Image size 2212x1659 · retinal fundus photograph:
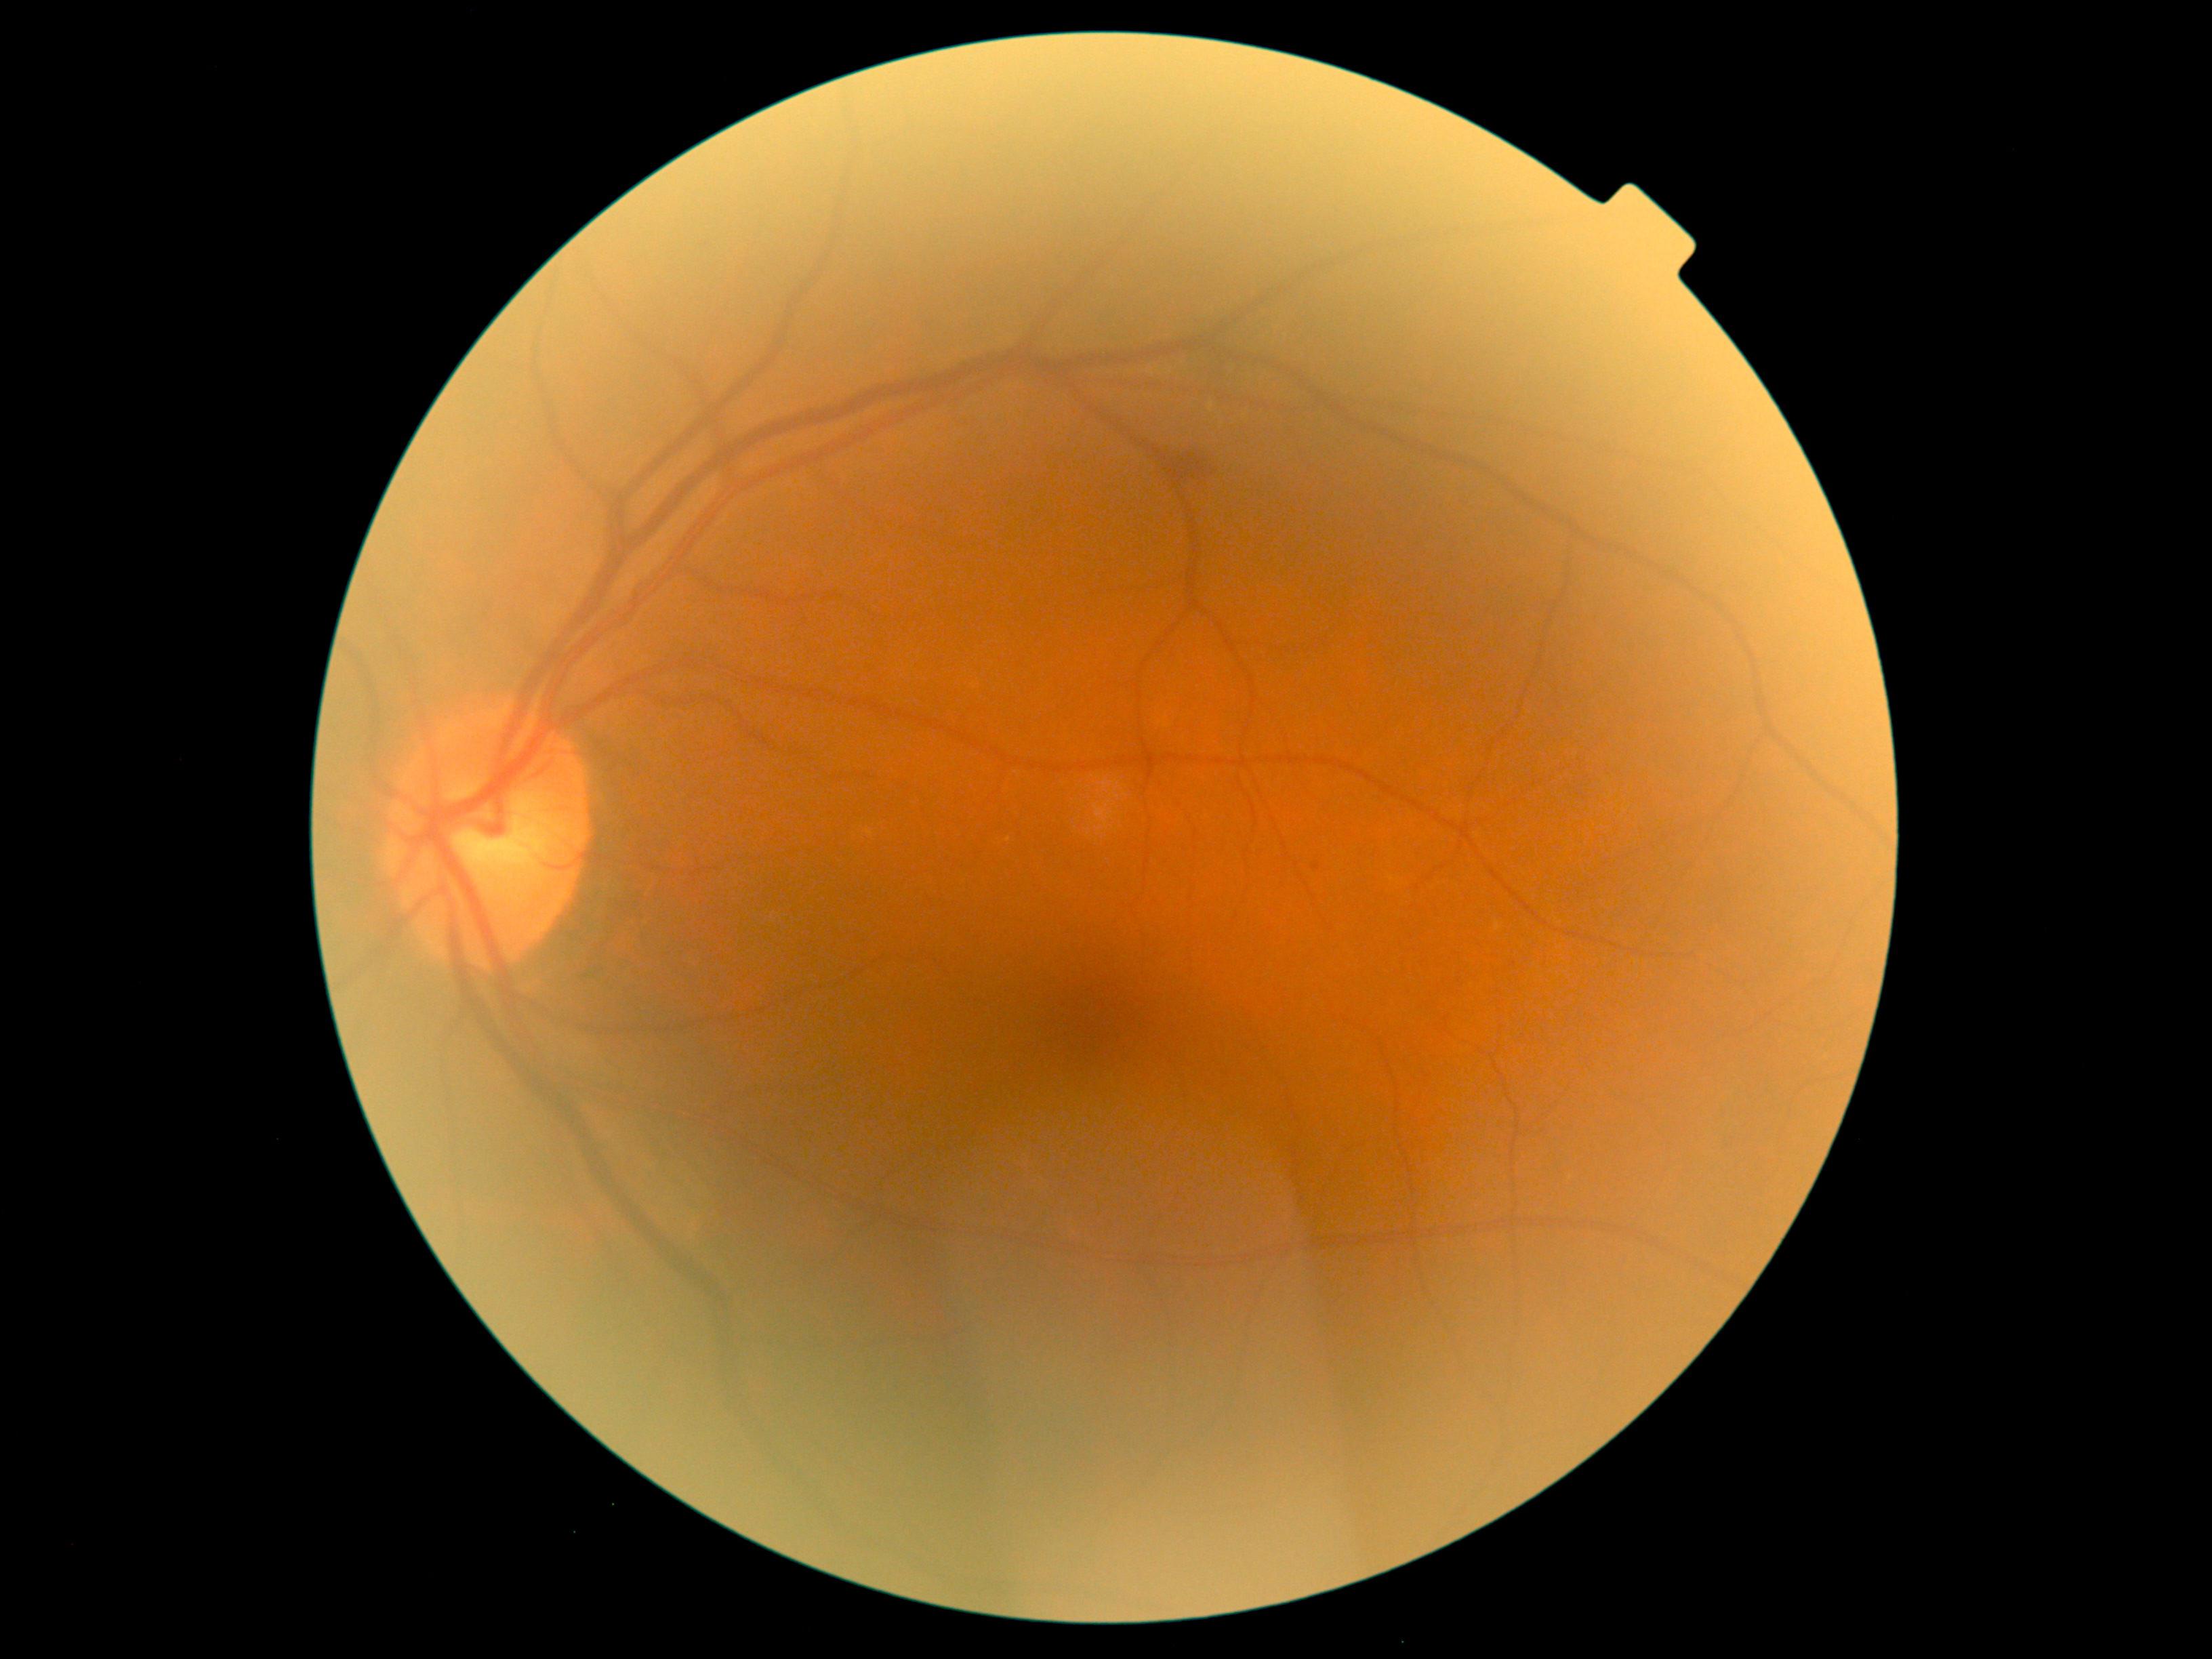
{
  "dr_grade": "grade 2"
}